Graded on the modified Davis scale — 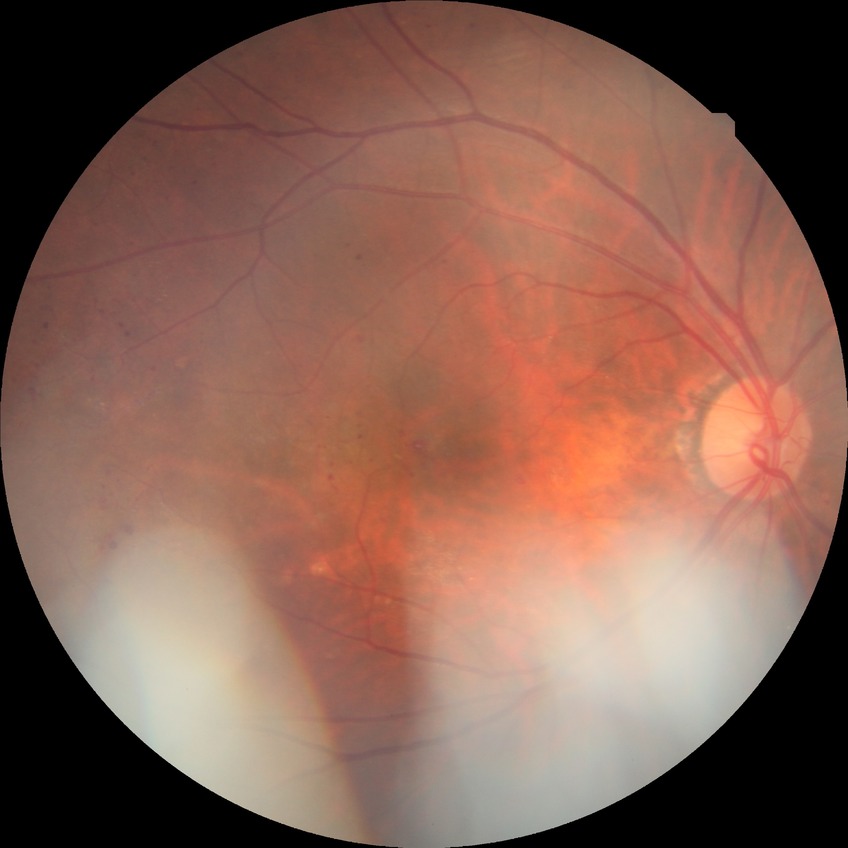 - DR class — non-proliferative diabetic retinopathy
- diabetic retinopathy (DR) — PPDR (pre-proliferative diabetic retinopathy)